2352x1568.
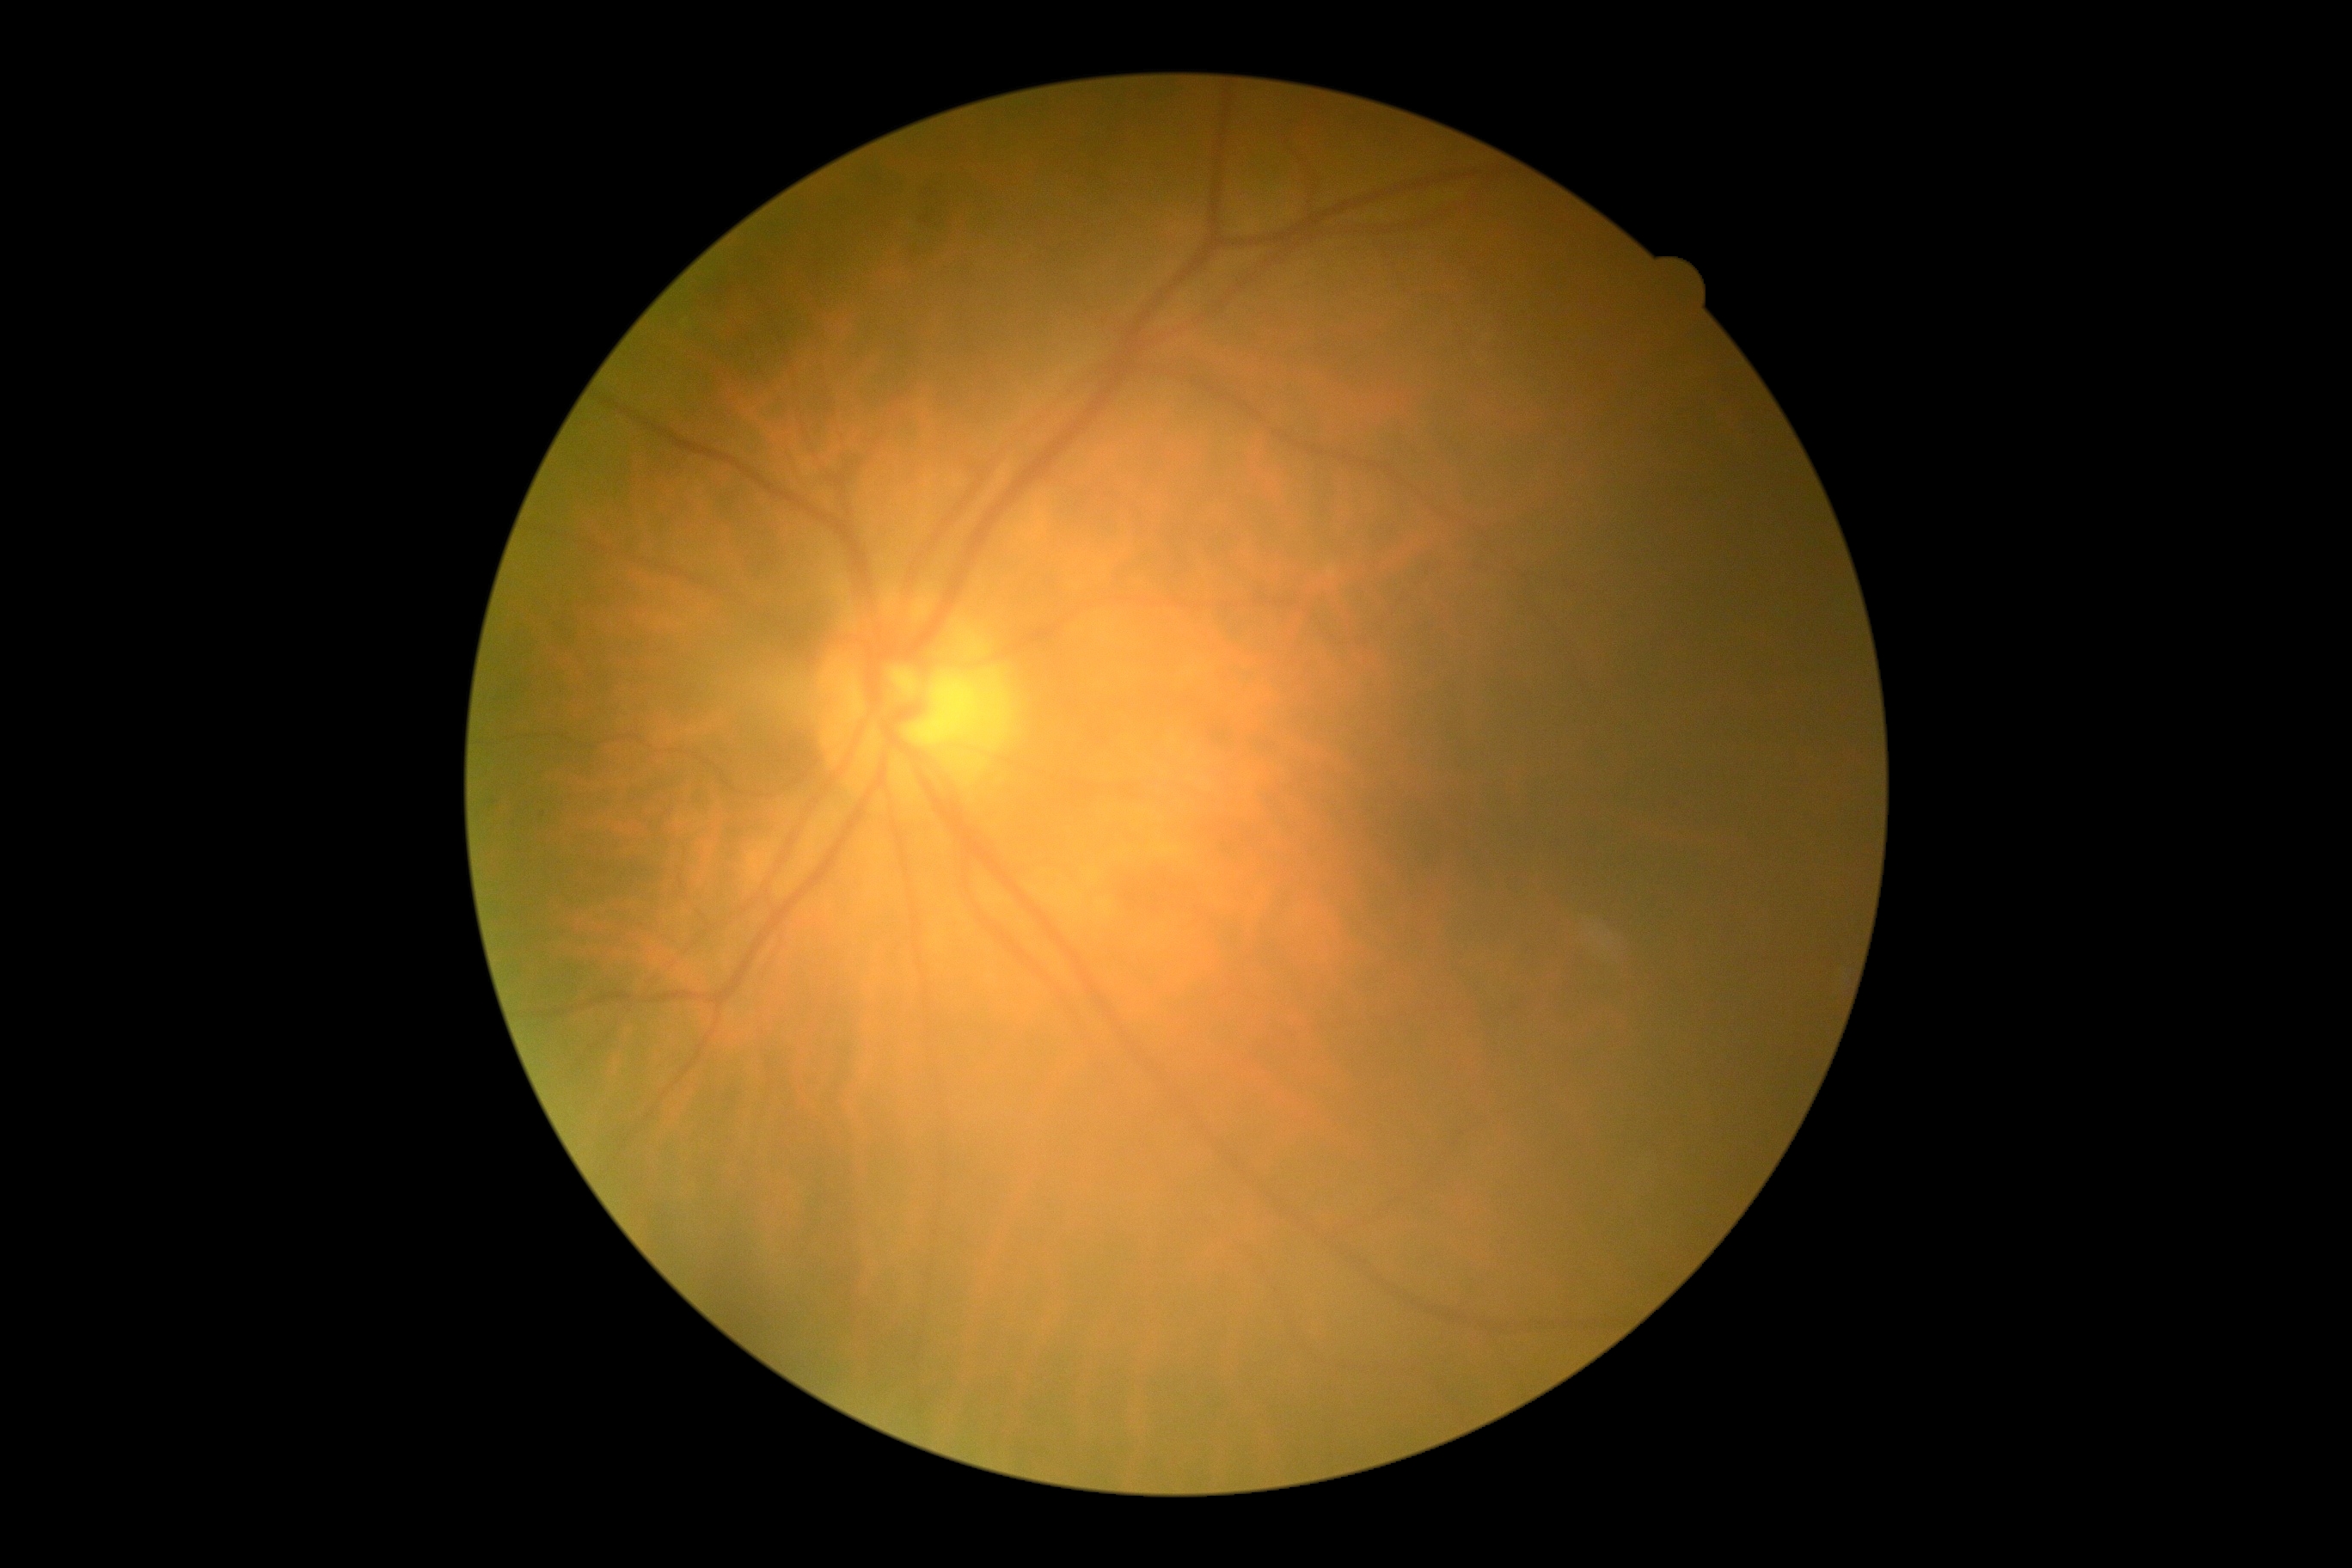
DR: moderate non-proliferative diabetic retinopathy (grade 2).